Mydriatic (tropicamide 0.5%); 50° field of view
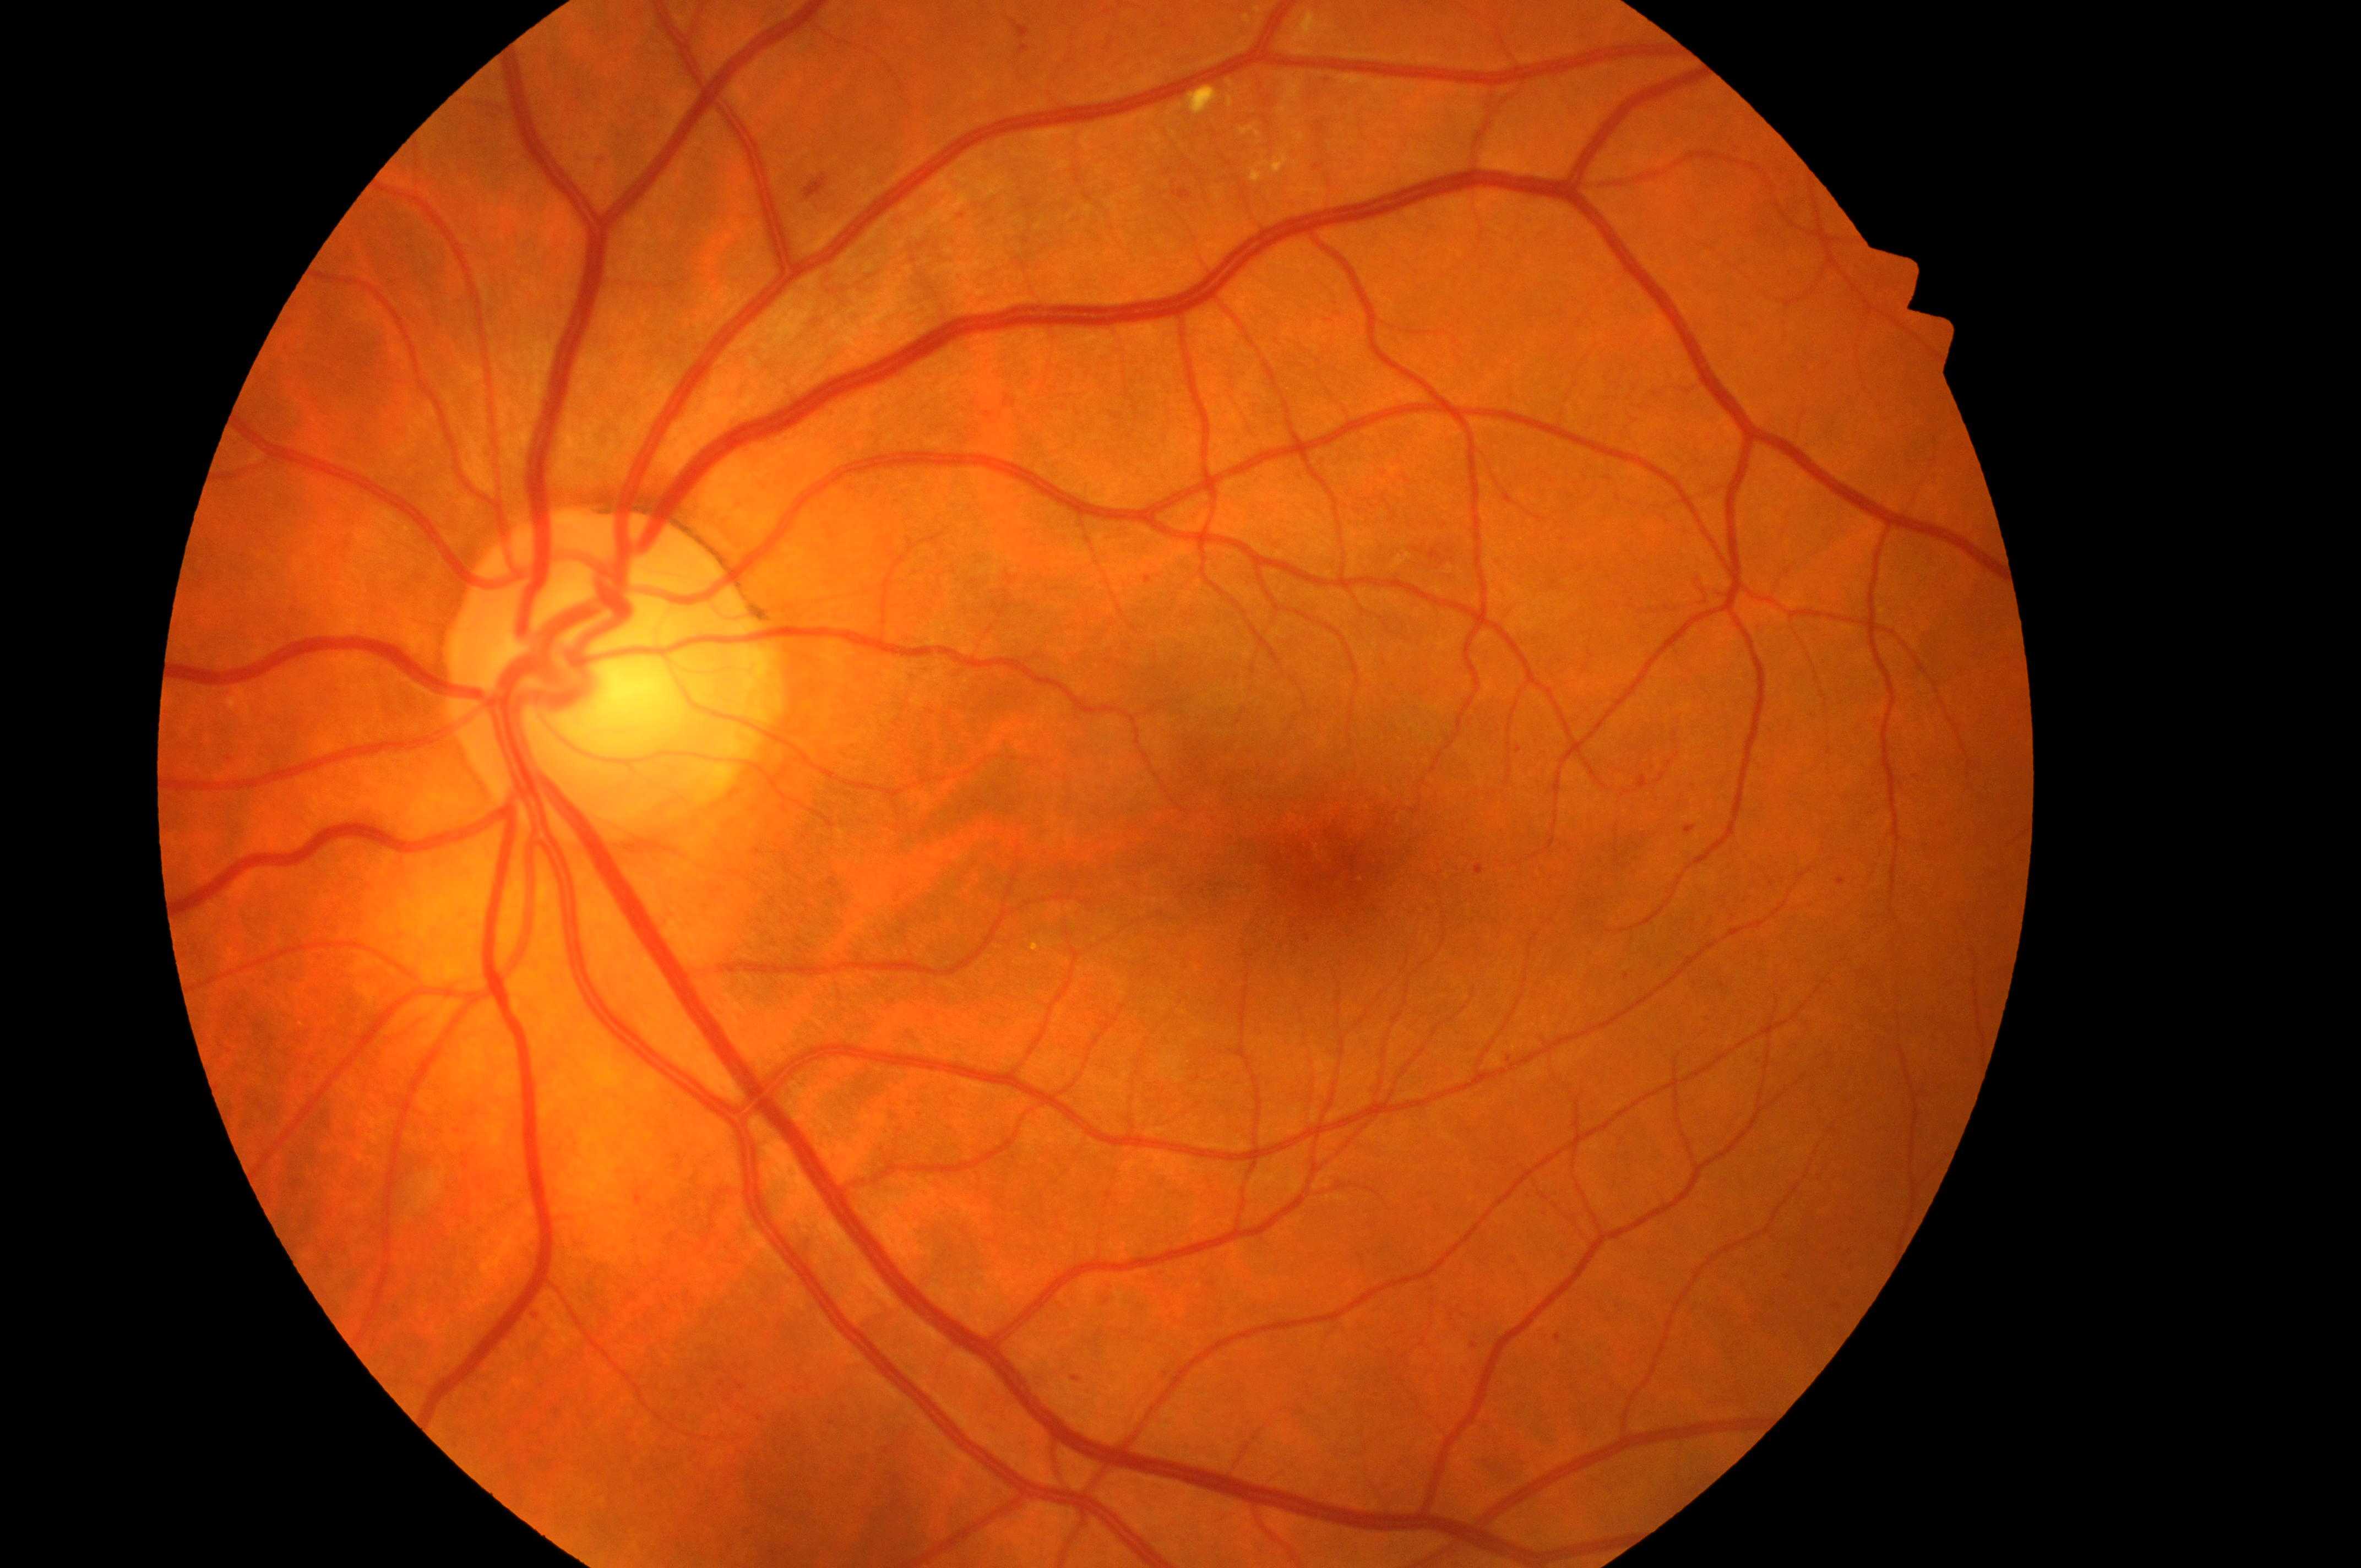

  dr_grade: 2
  dme_grade: 1/2
  fovea: [1328, 870]
  optic_disc: [600, 690]
  eye: oculus sinister